DR severity per modified Davis staging:
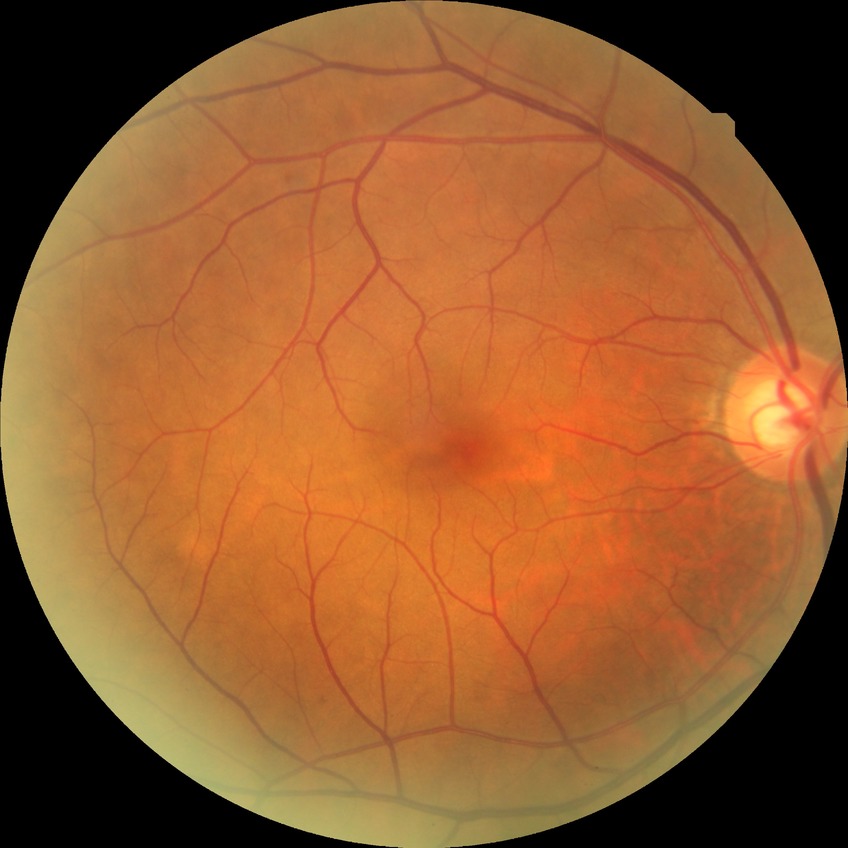

diabetic retinopathy (DR)@no diabetic retinopathy (NDR).